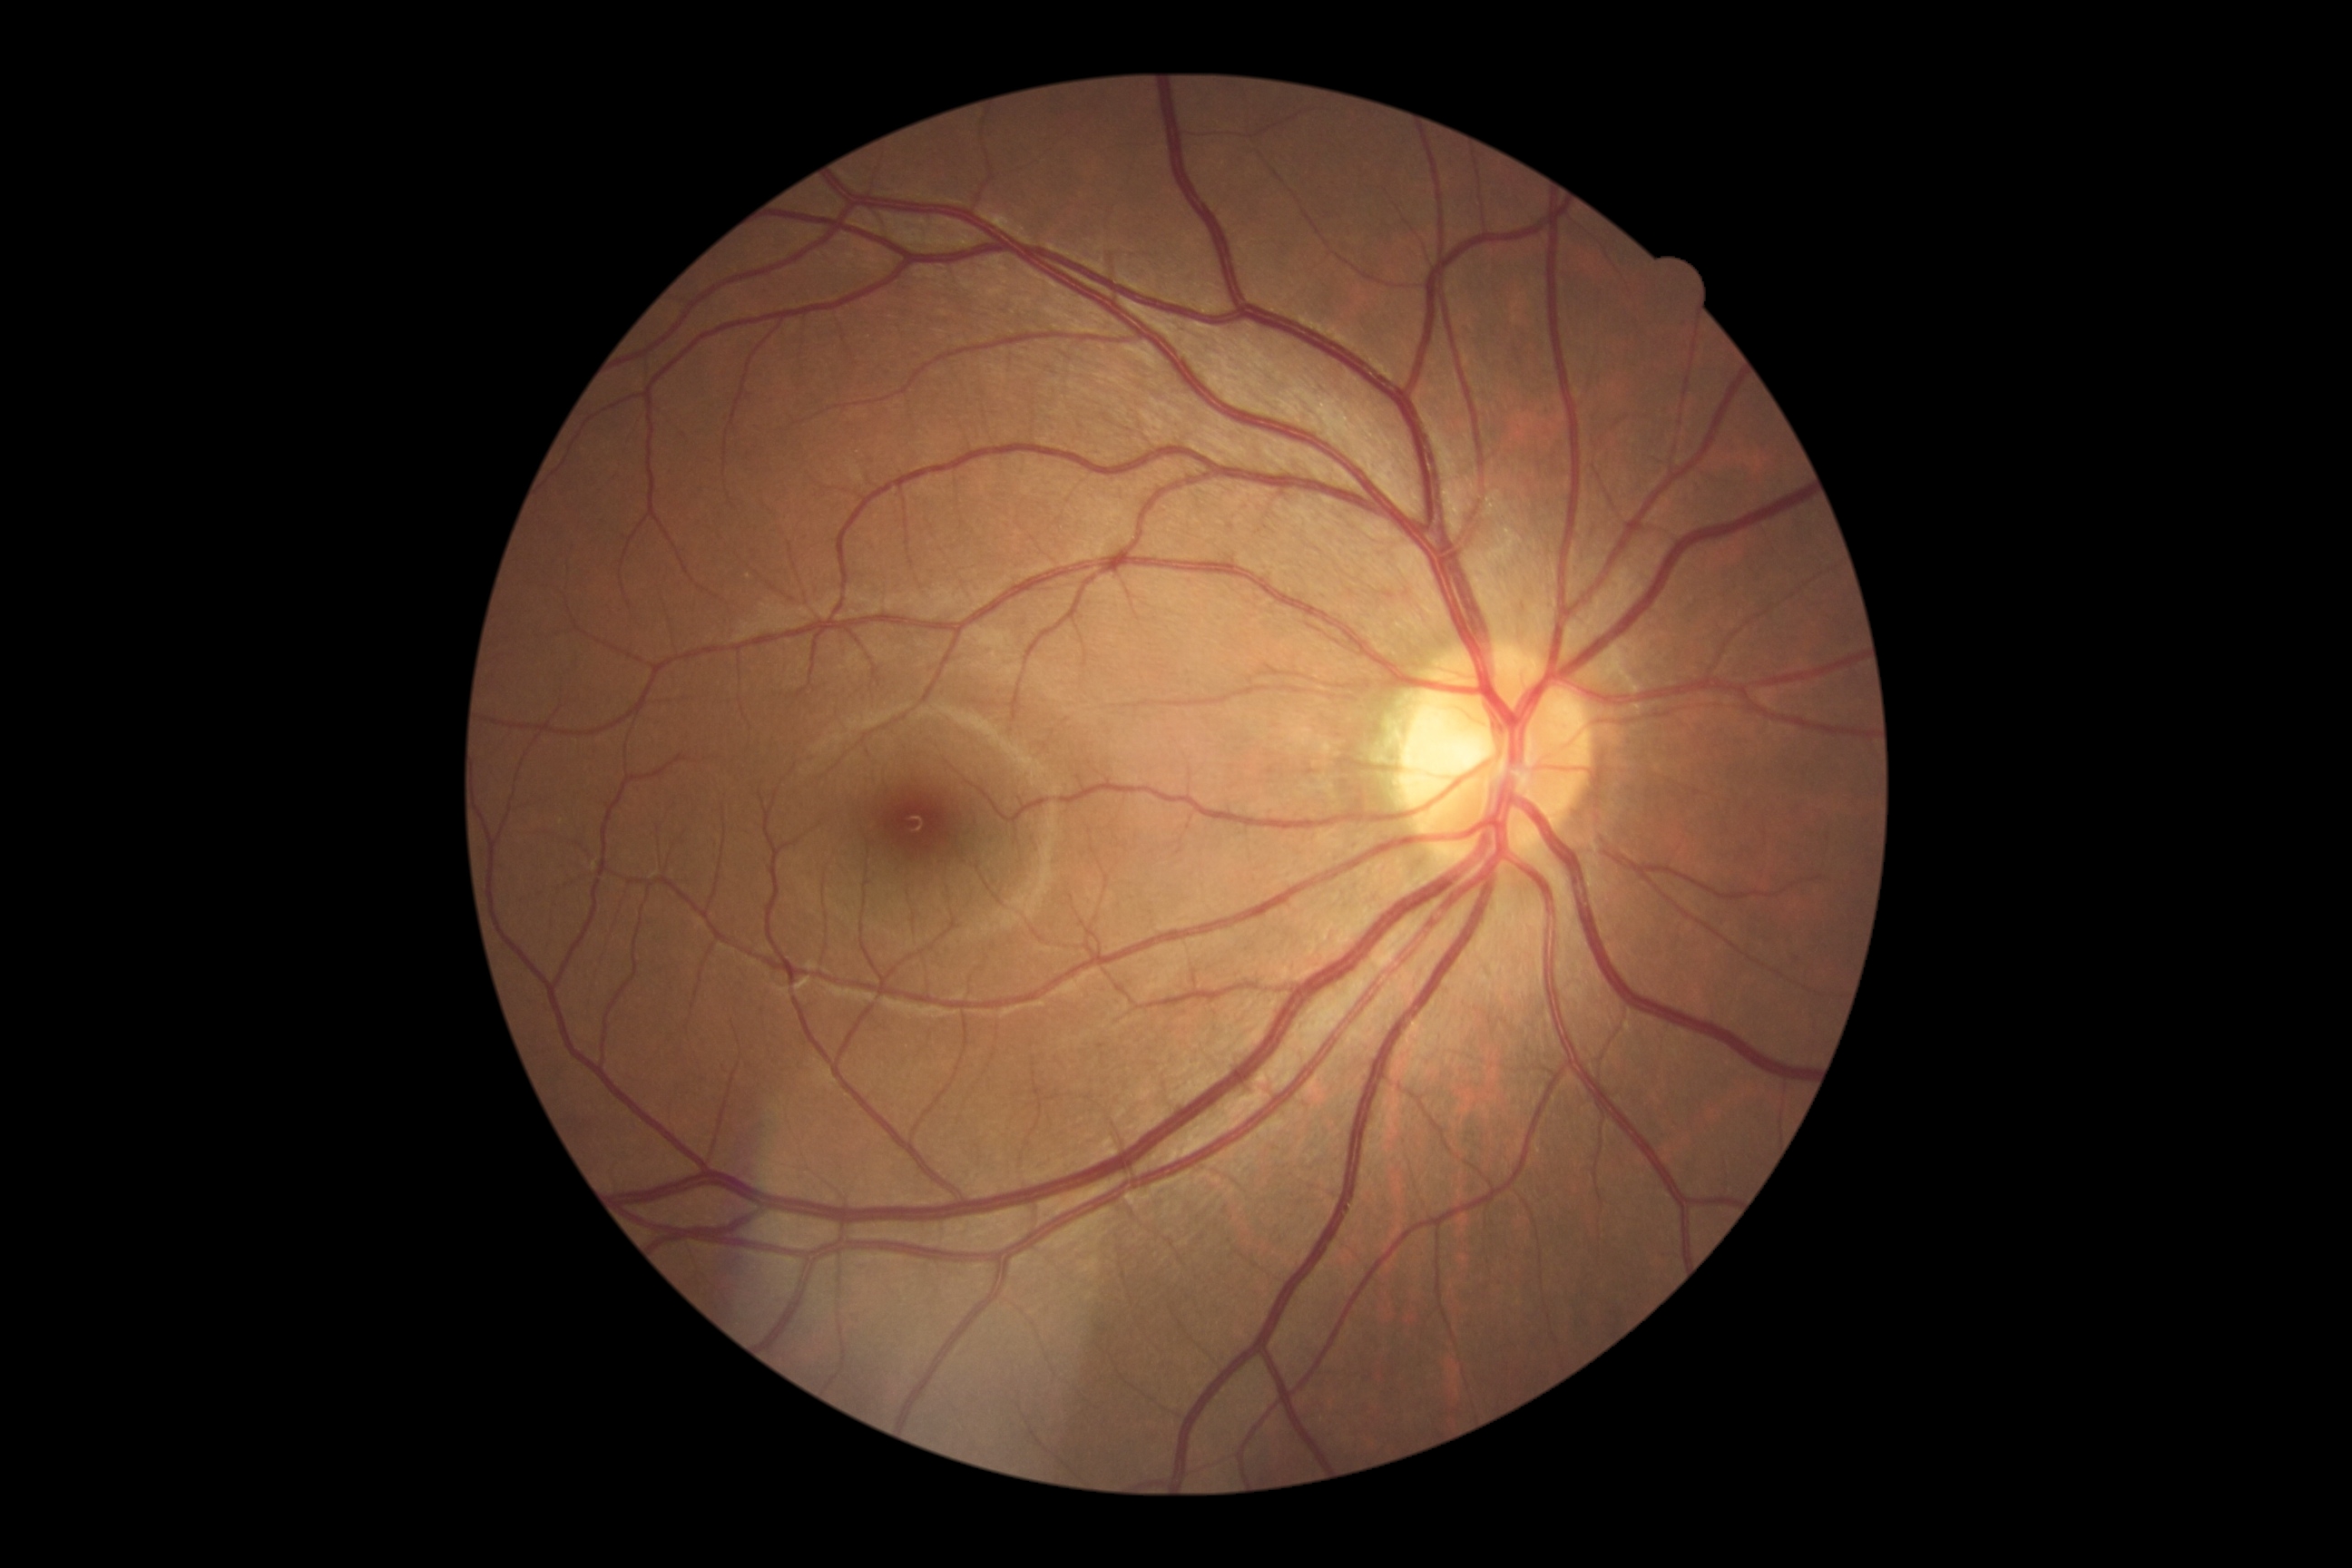 No DR findings. Diabetic retinopathy (DR) is 0.